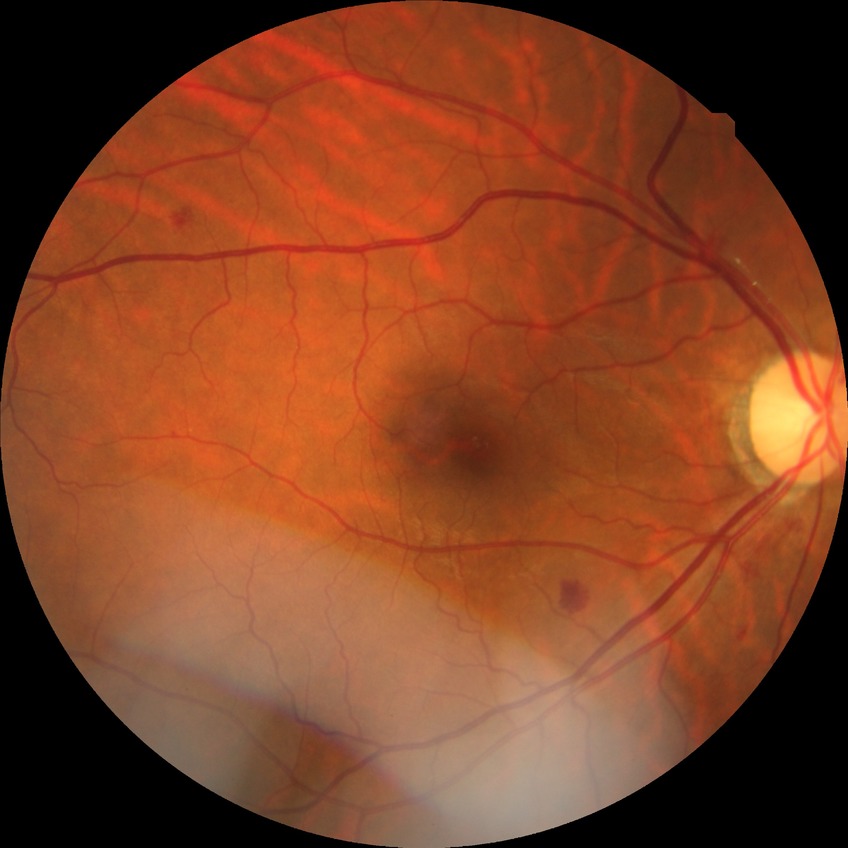 {"davis_grade": "simple diabetic retinopathy"}